Modified Davis grading
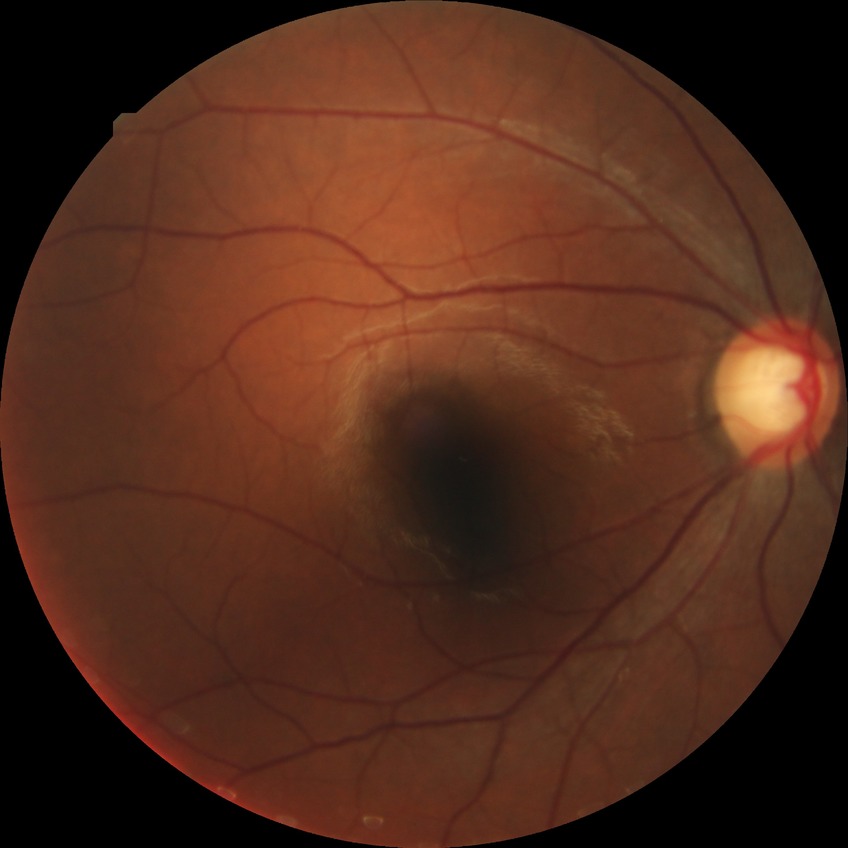

No signs of diabetic retinopathy. Davis stage: NDR.